1536x1152
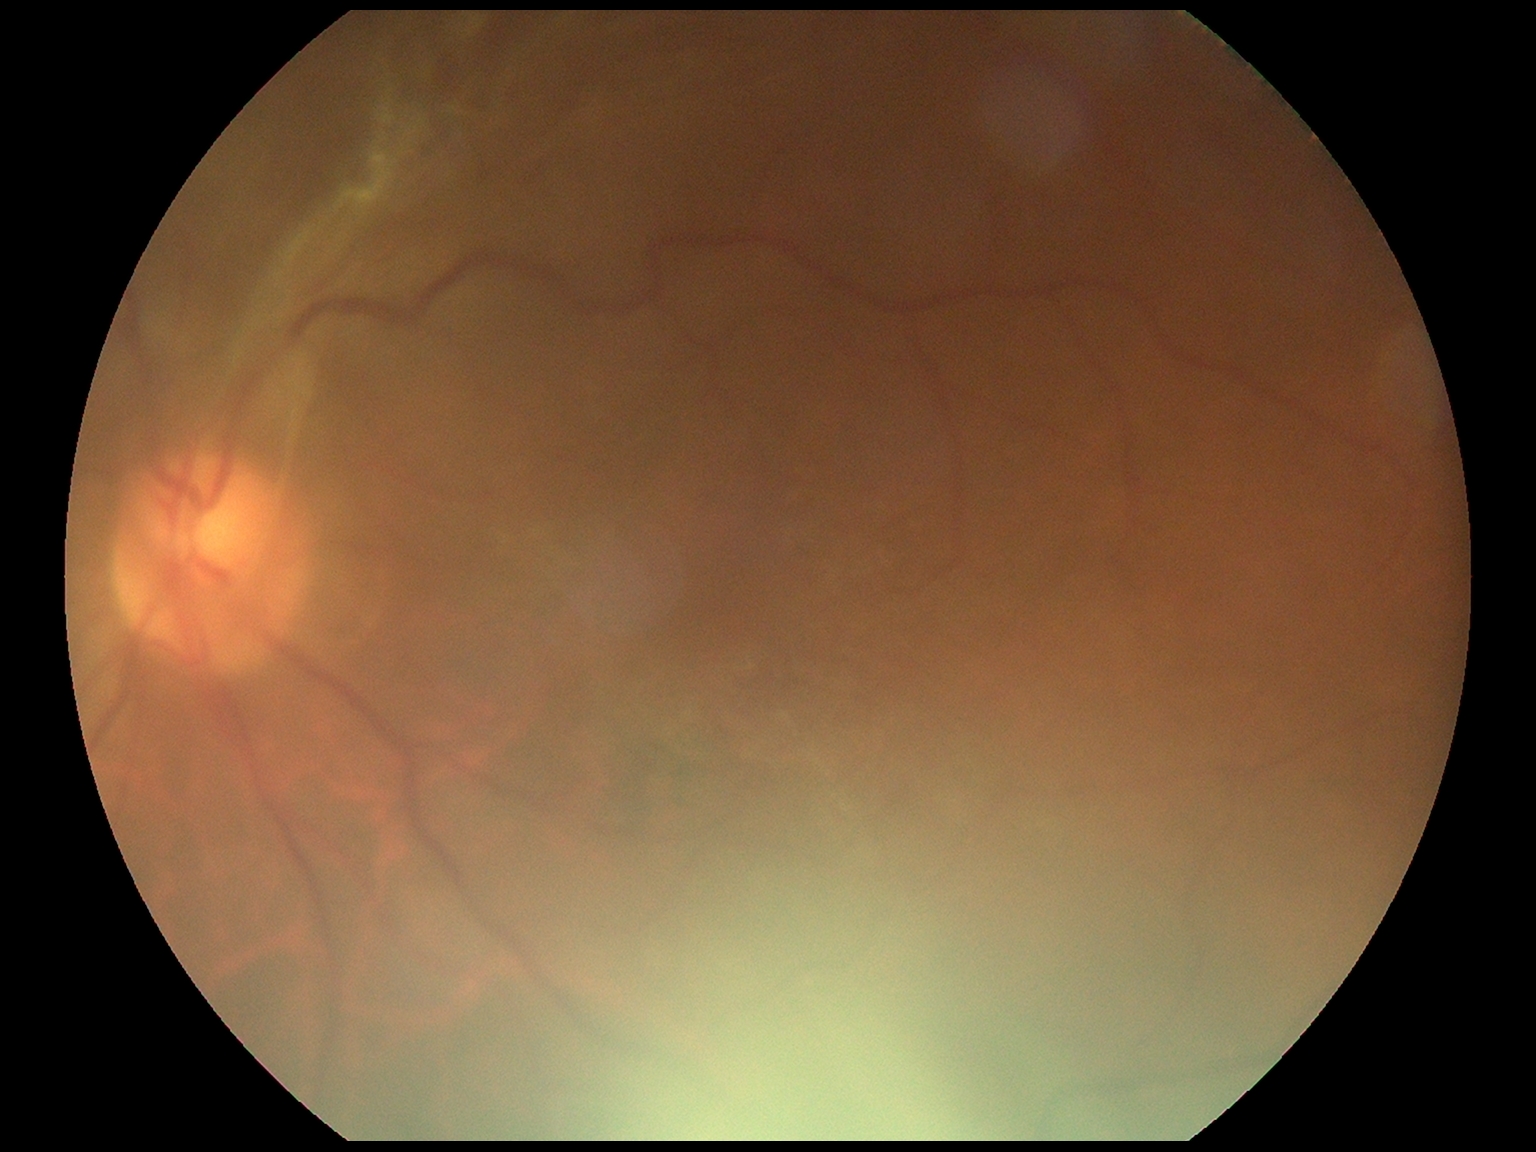
DR class: proliferative diabetic retinopathy, retinopathy grade: PDR (4).